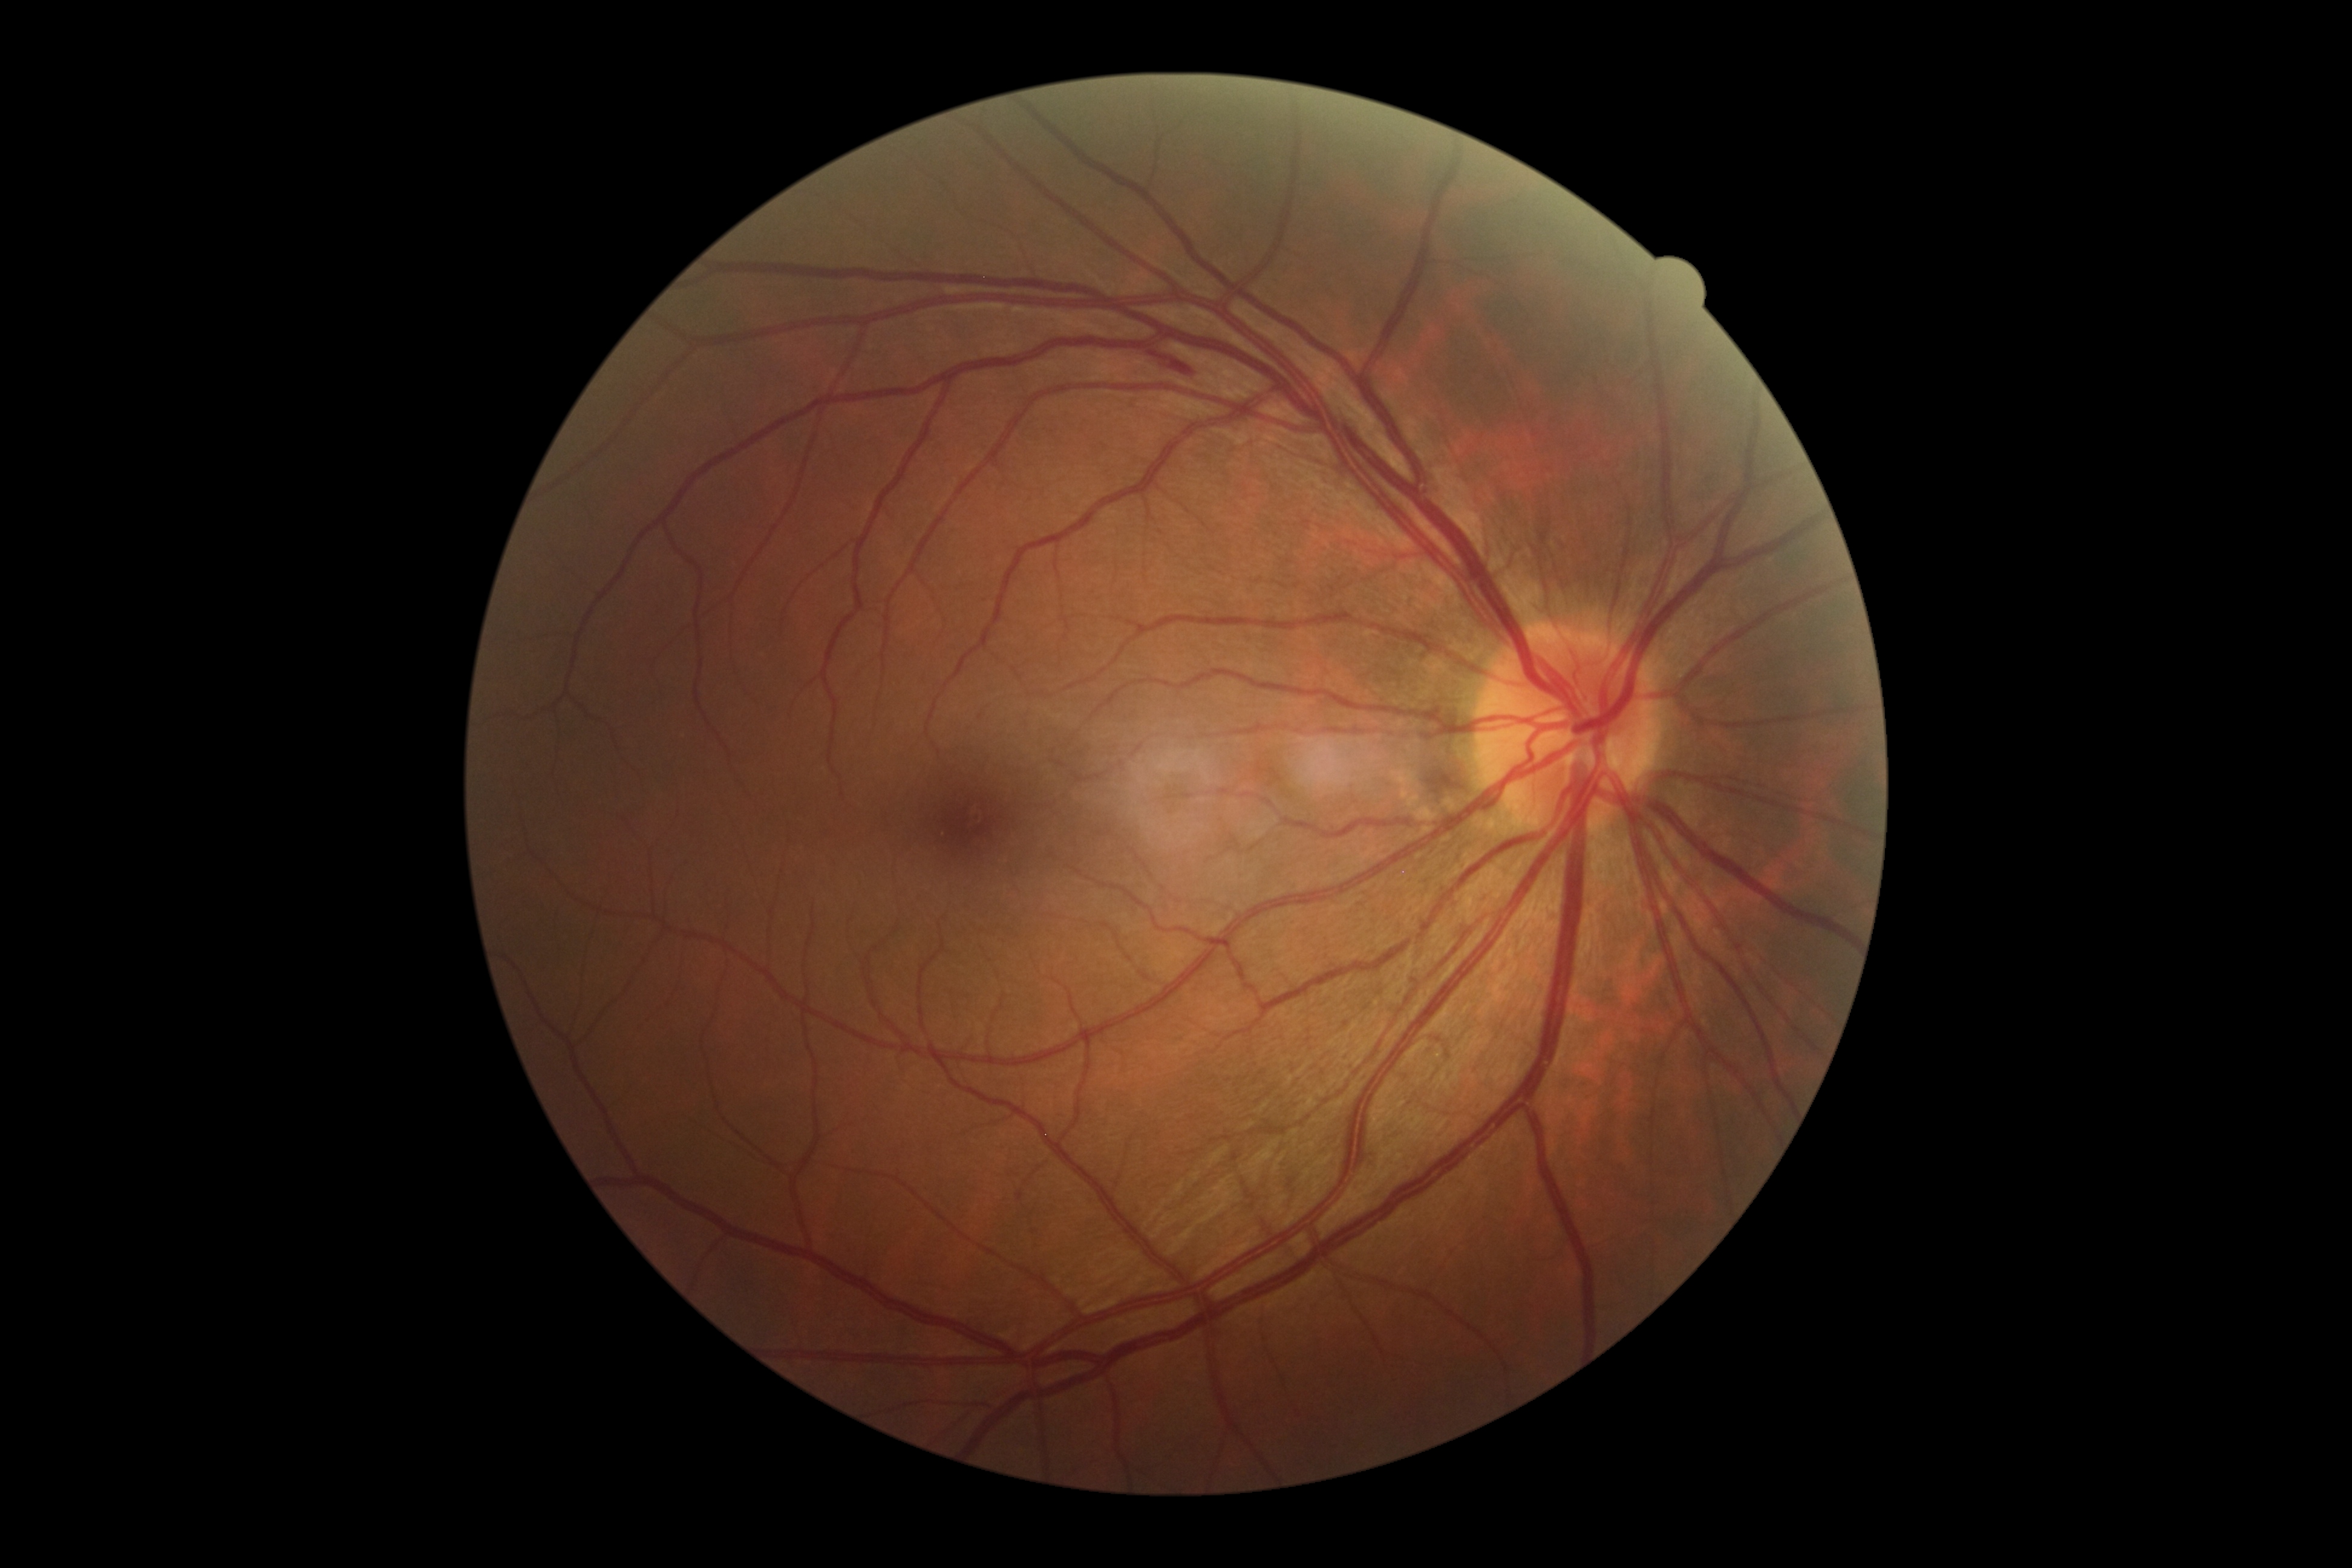 Annotations:
– DR class — non-proliferative diabetic retinopathy
– DR stage — 2/4